848 x 848 pixels, DR severity per modified Davis staging: 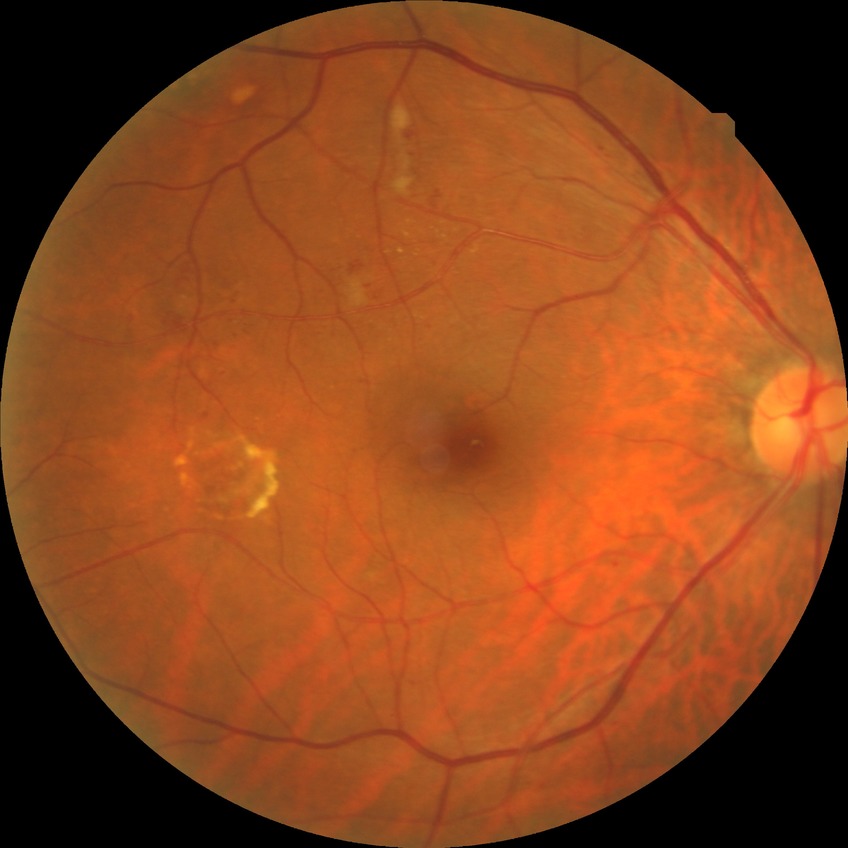

DR class: non-proliferative diabetic retinopathy.
Modified Davis grade: SDR.